Color fundus photograph centered on the optic disc: 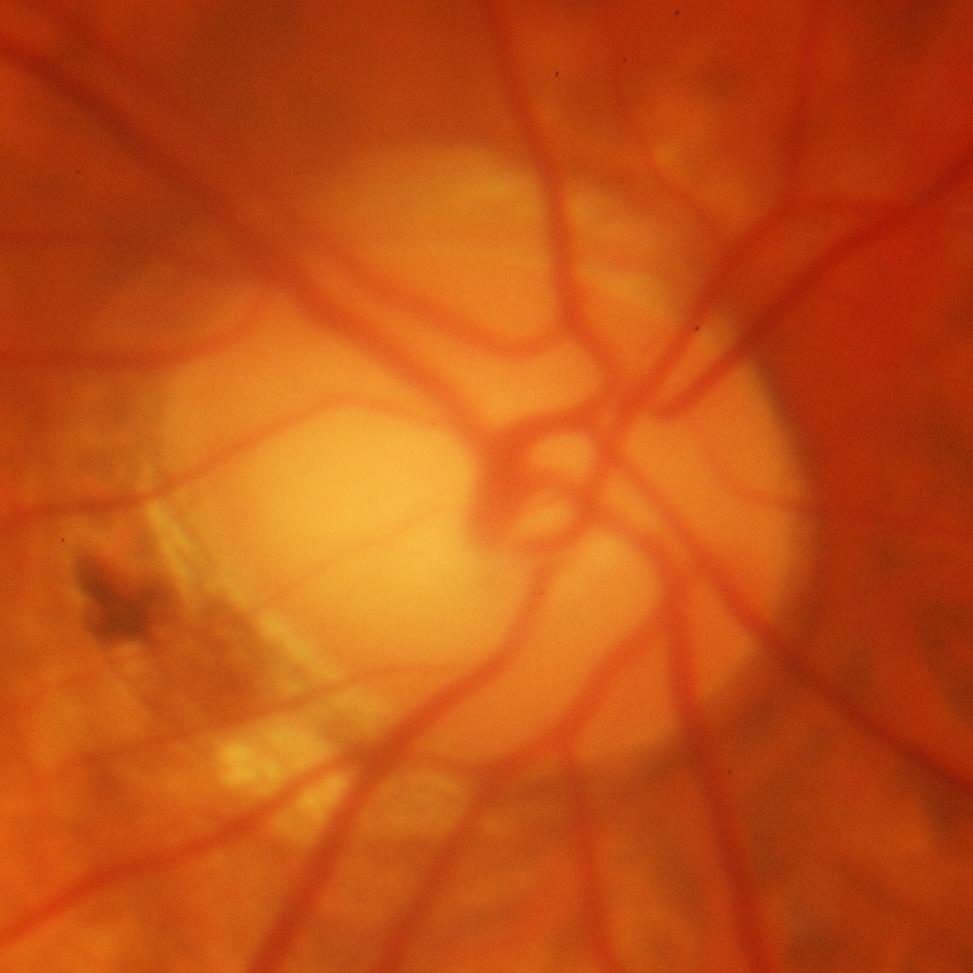 Glaucomatous optic neuropathy is present.
Glaucomatous damage to the optic nerve.